UWF retinal mosaic
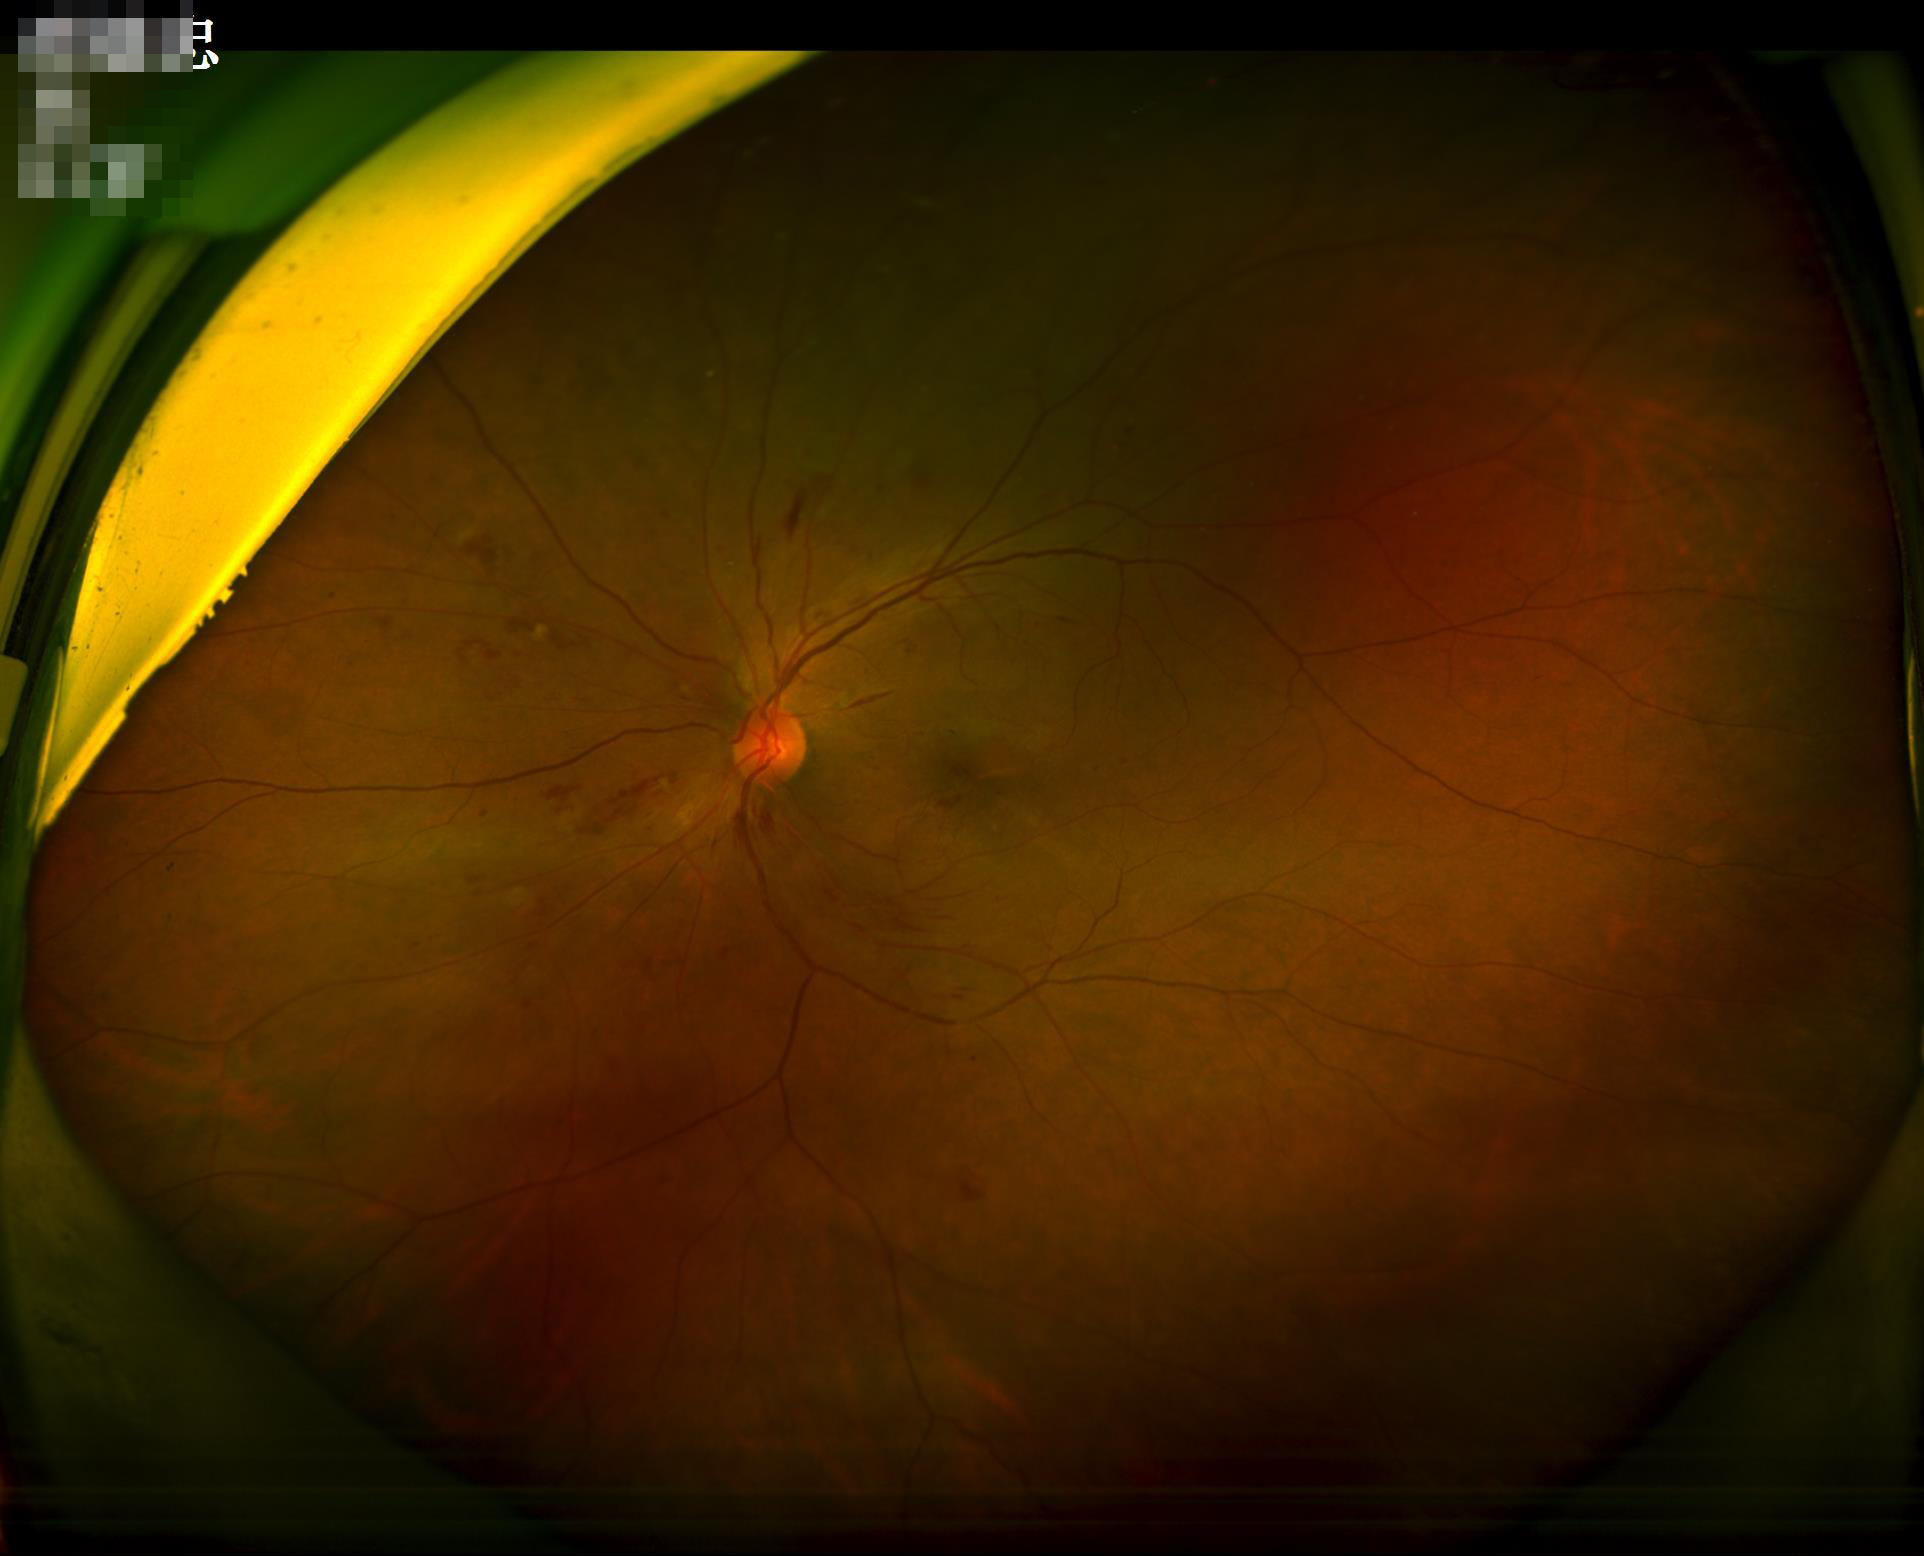

Quality grading: sharpness: clear with no noticeable blur | illumination/color: inadequate, with uneven exposure or color distortion | overall: good, gradable.